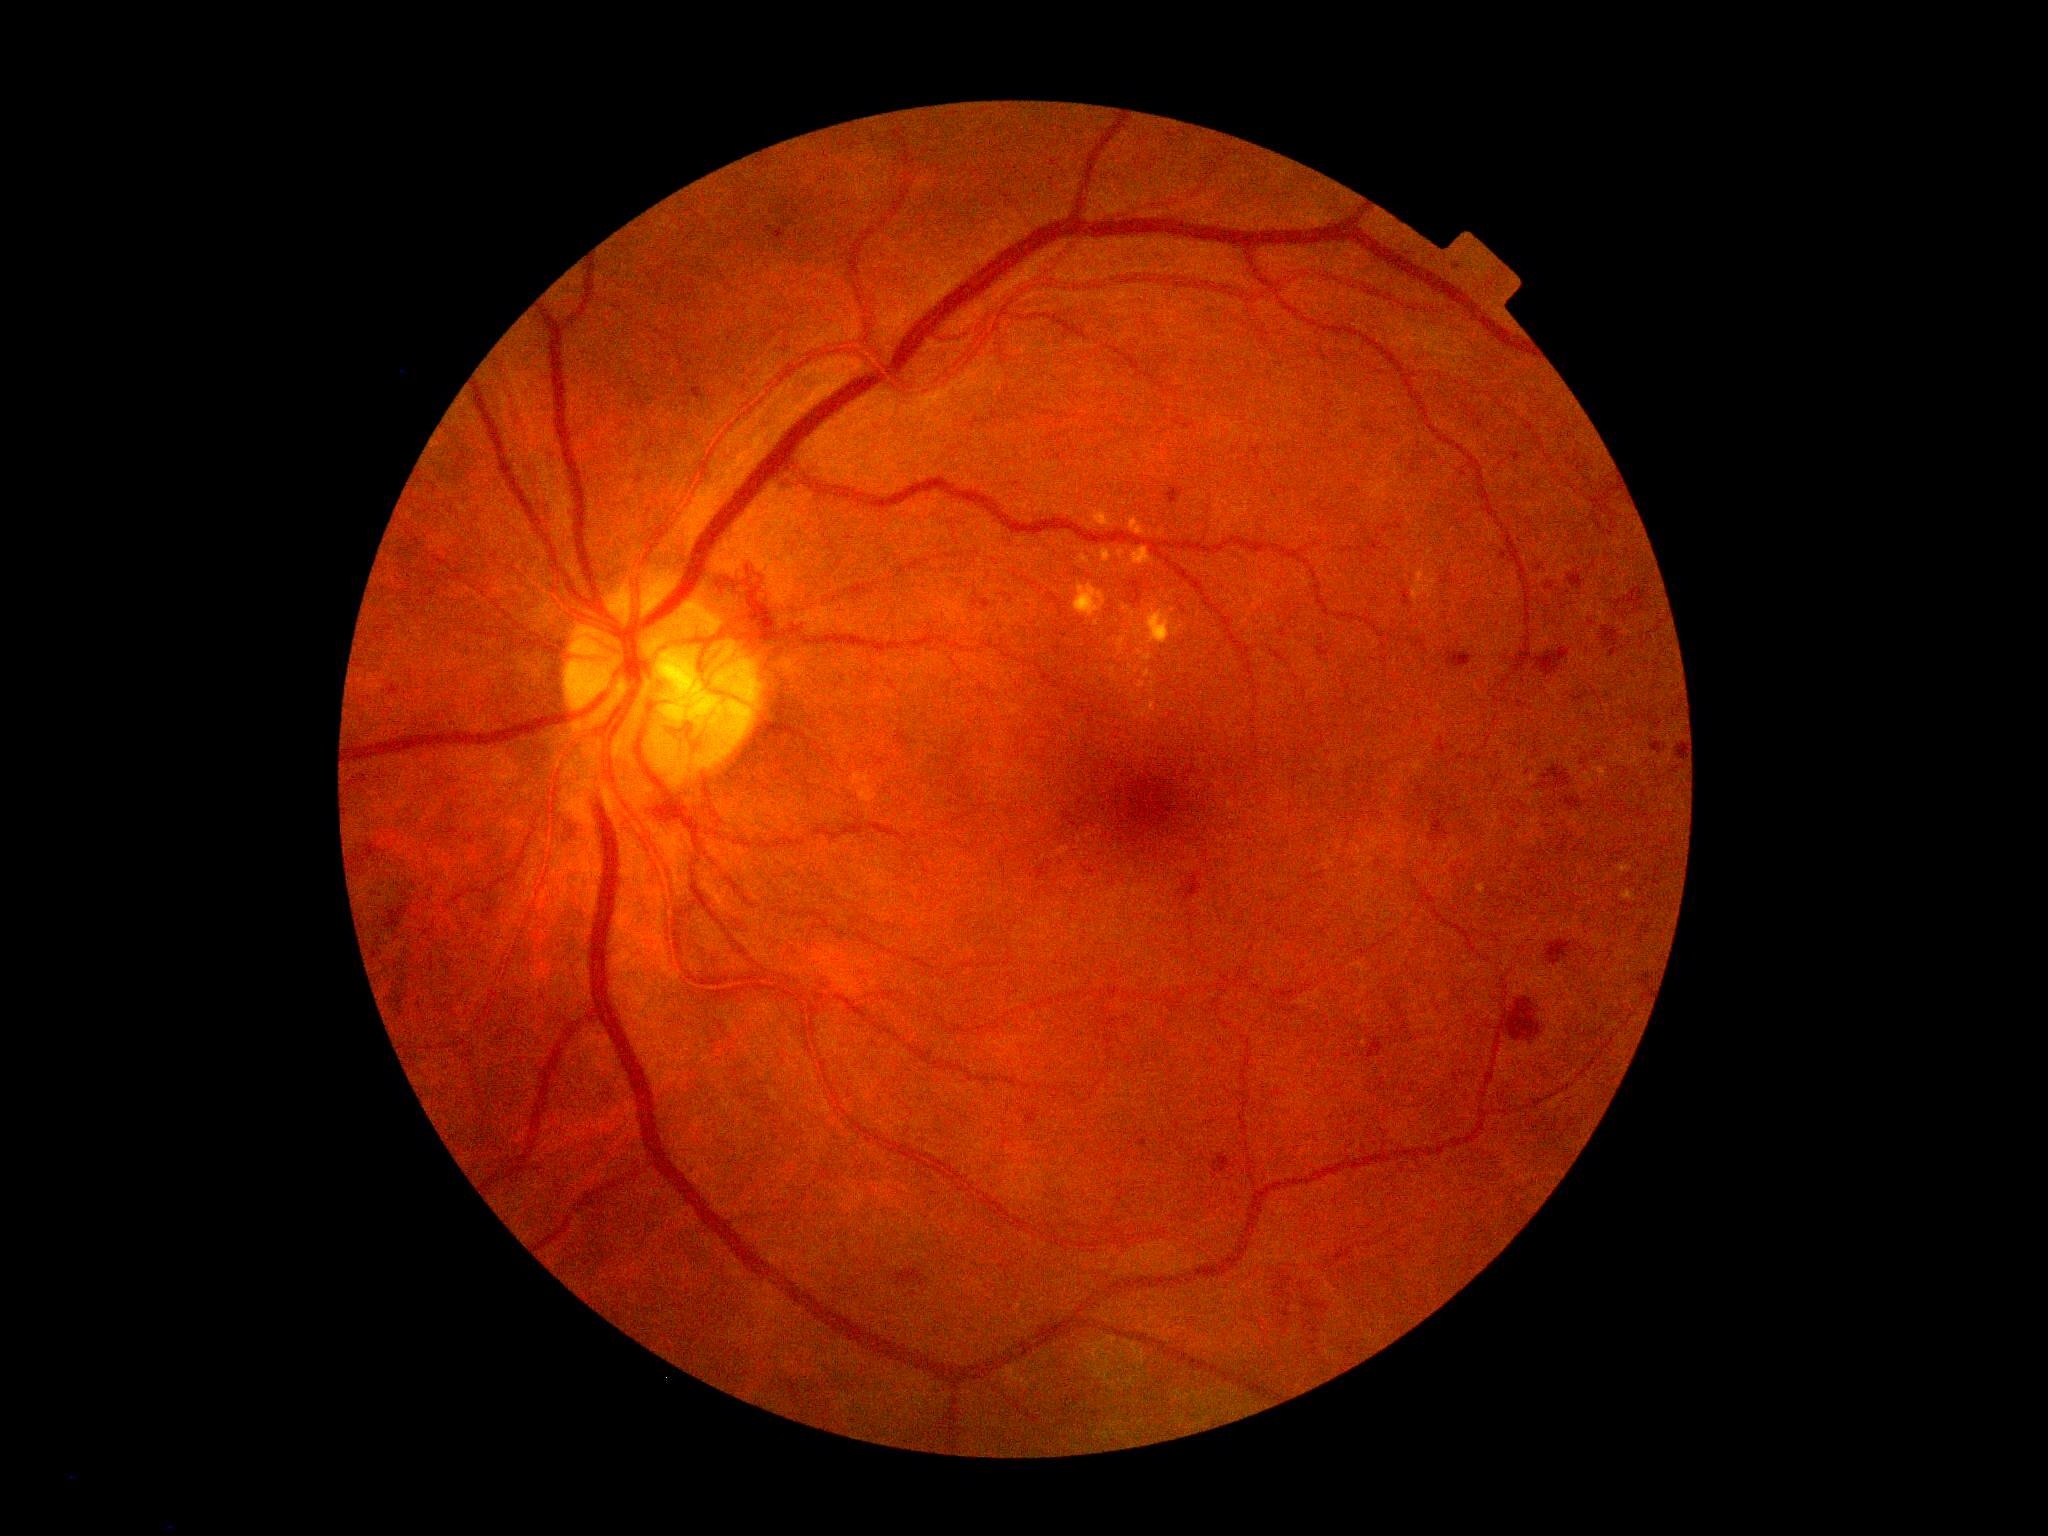
Diabetic retinopathy is grade 4 (PDR); proliferative diabetic retinopathy
A subset of detected lesions:
hemorrhages (subset) = left=1186, top=876, right=1203, bottom=901 | left=1570, top=575, right=1583, bottom=587 | left=1448, top=652, right=1472, bottom=668 | left=1548, top=941, right=1570, bottom=965 | left=1451, top=260, right=1465, bottom=273 | left=1652, top=743, right=1662, bottom=751 | left=556, top=815, right=585, bottom=847 | left=1007, top=480, right=1024, bottom=492 | left=693, top=388, right=702, bottom=399 | left=1369, top=1043, right=1385, bottom=1059 | left=1438, top=738, right=1446, bottom=753 | left=1501, top=998, right=1541, bottom=1040 | left=1169, top=489, right=1178, bottom=505
Additional small hemorrhages near 1613/652 | 1592/623 | 1421/792 | 1616/642 | 1540/569 | 1648/976
microaneurysms = none
hard exudates (subset) = left=1149, top=612, right=1170, bottom=644 | left=1414, top=591, right=1418, bottom=599 | left=1130, top=520, right=1143, bottom=534 | left=1419, top=574, right=1424, bottom=583 | left=1479, top=885, right=1485, bottom=893 | left=1074, top=586, right=1100, bottom=616 | left=1135, top=549, right=1150, bottom=563 | left=1096, top=514, right=1109, bottom=526 | left=1104, top=551, right=1110, bottom=561 | left=1624, top=892, right=1632, bottom=898
Additional small hard exudates near 1152/706 | 1148/674 | 1149/658 | 1625/869 | 1602/773
soft exudates = none